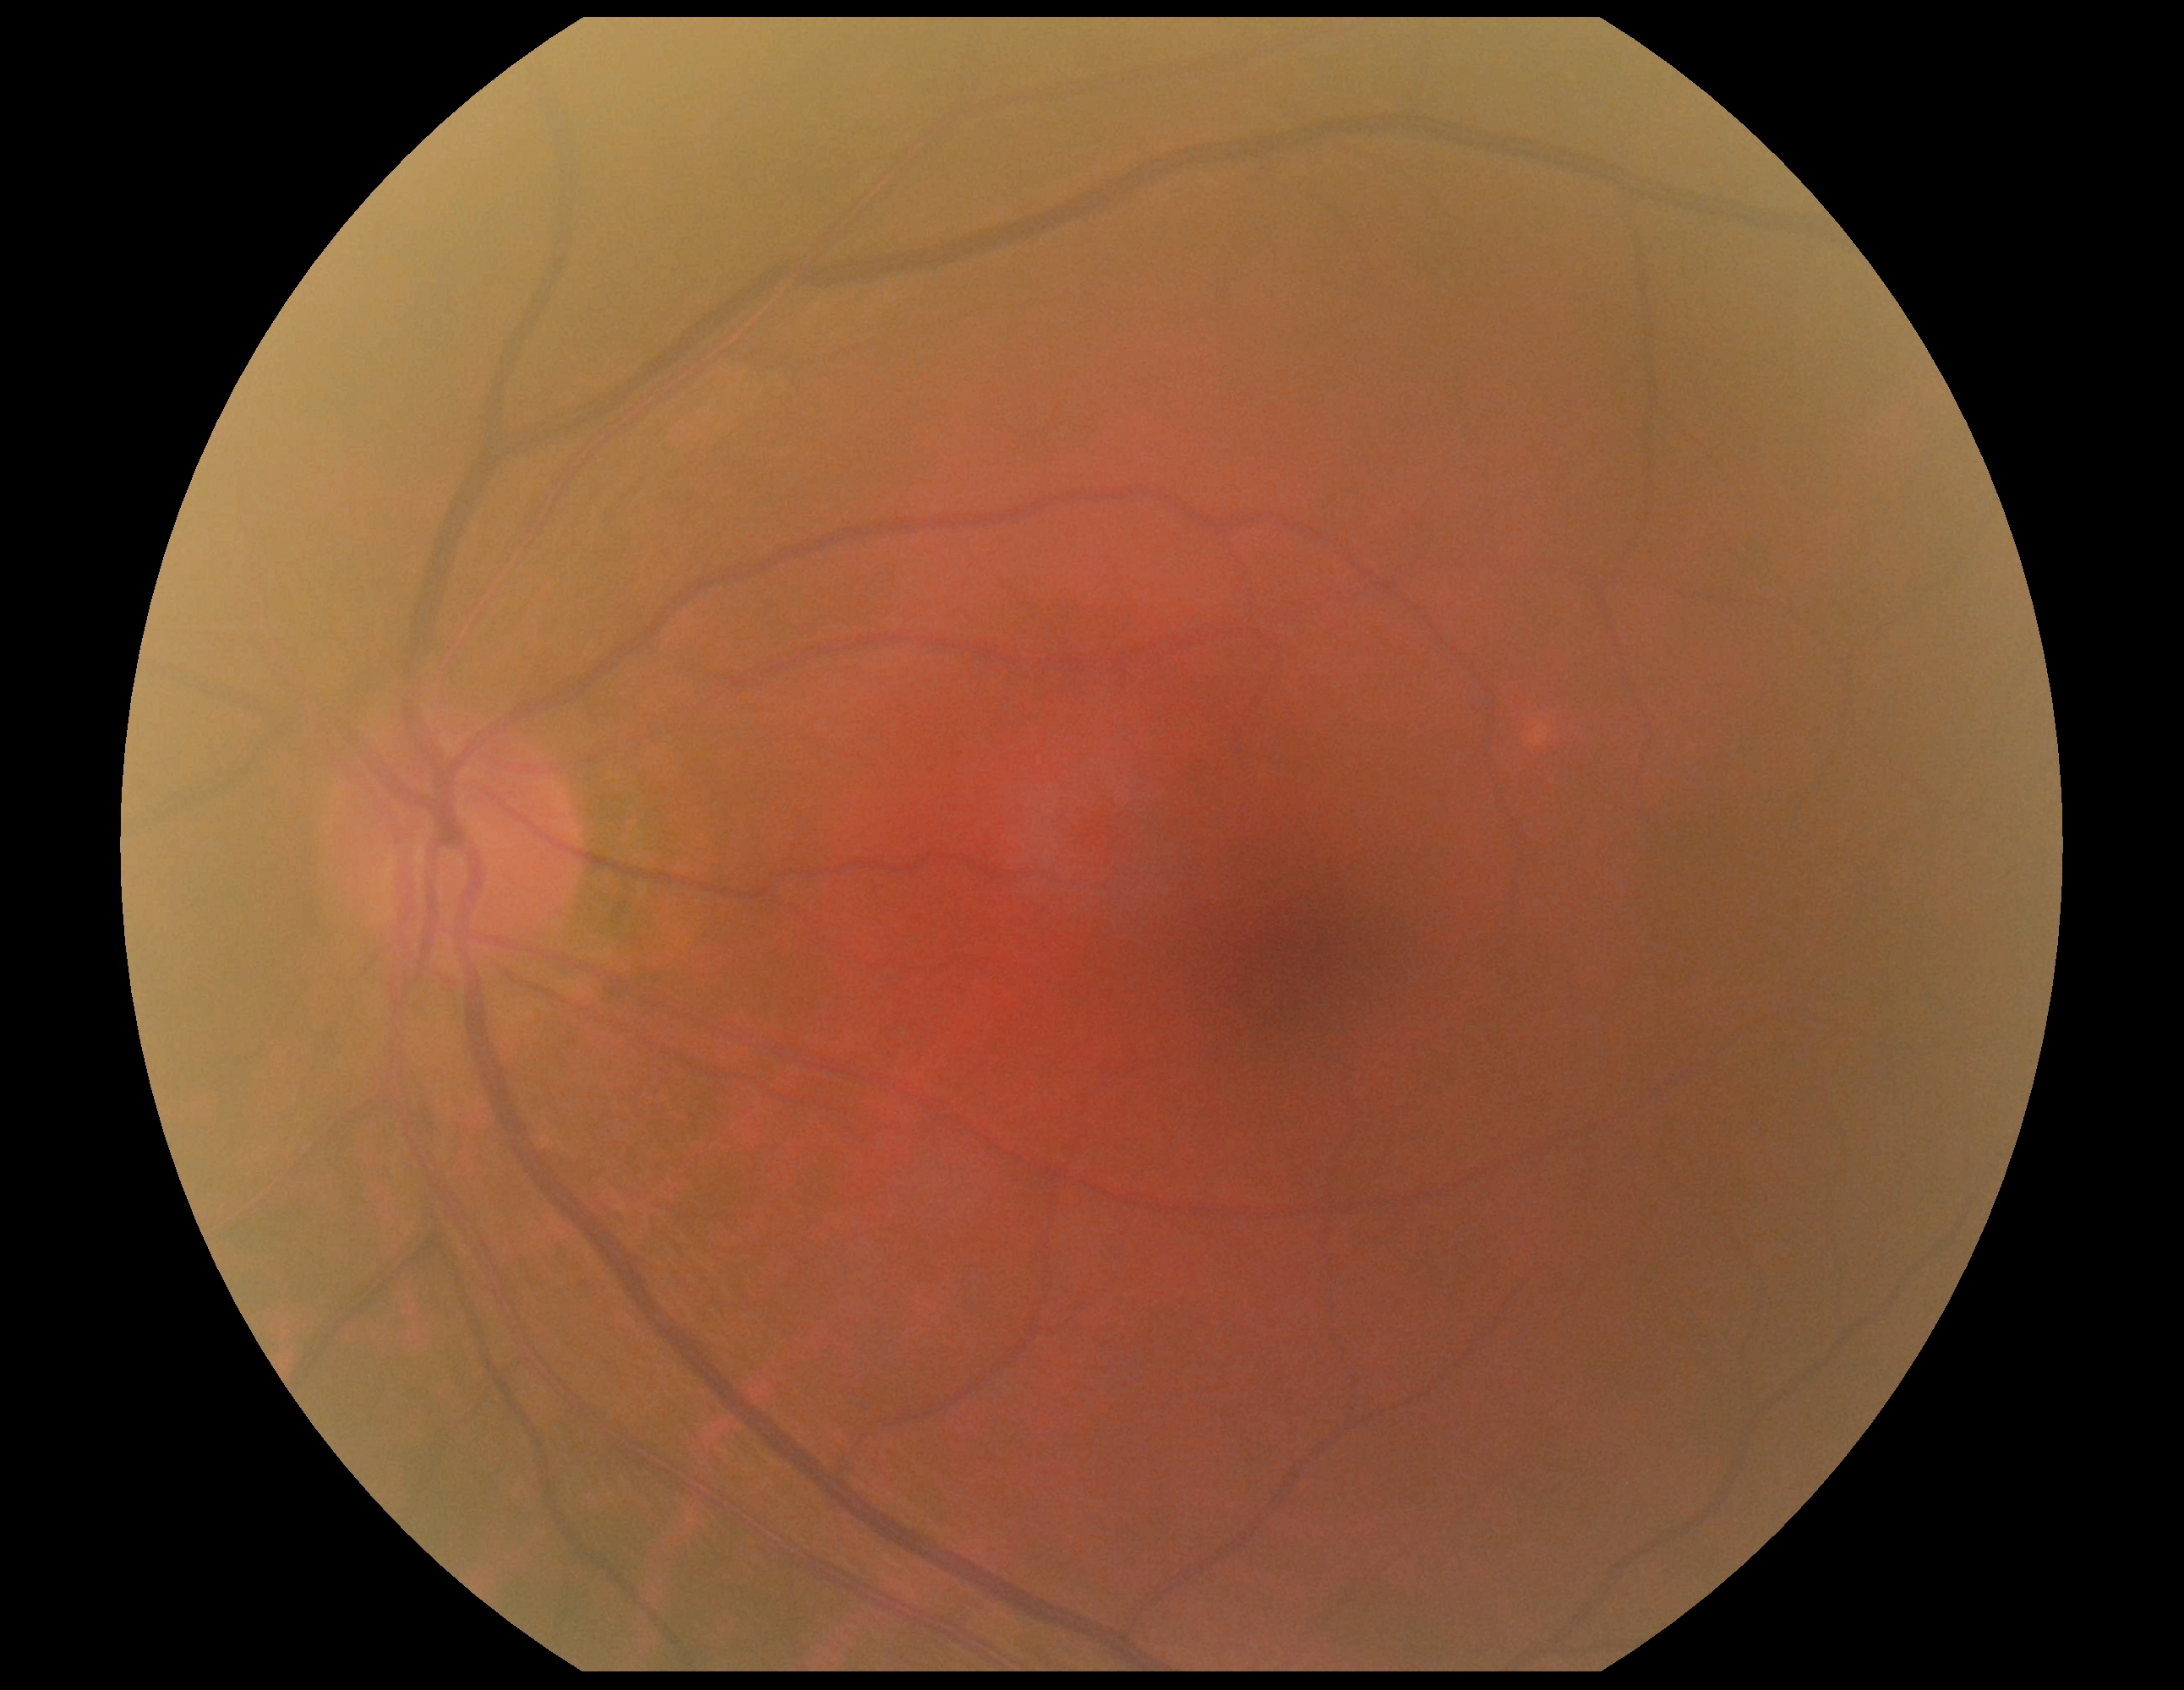 DR grade: 0 — no visible signs of diabetic retinopathy.